Wide-field contact fundus photograph of an infant. Image size 1240x1240. Phoenix ICON, 100° FOV:
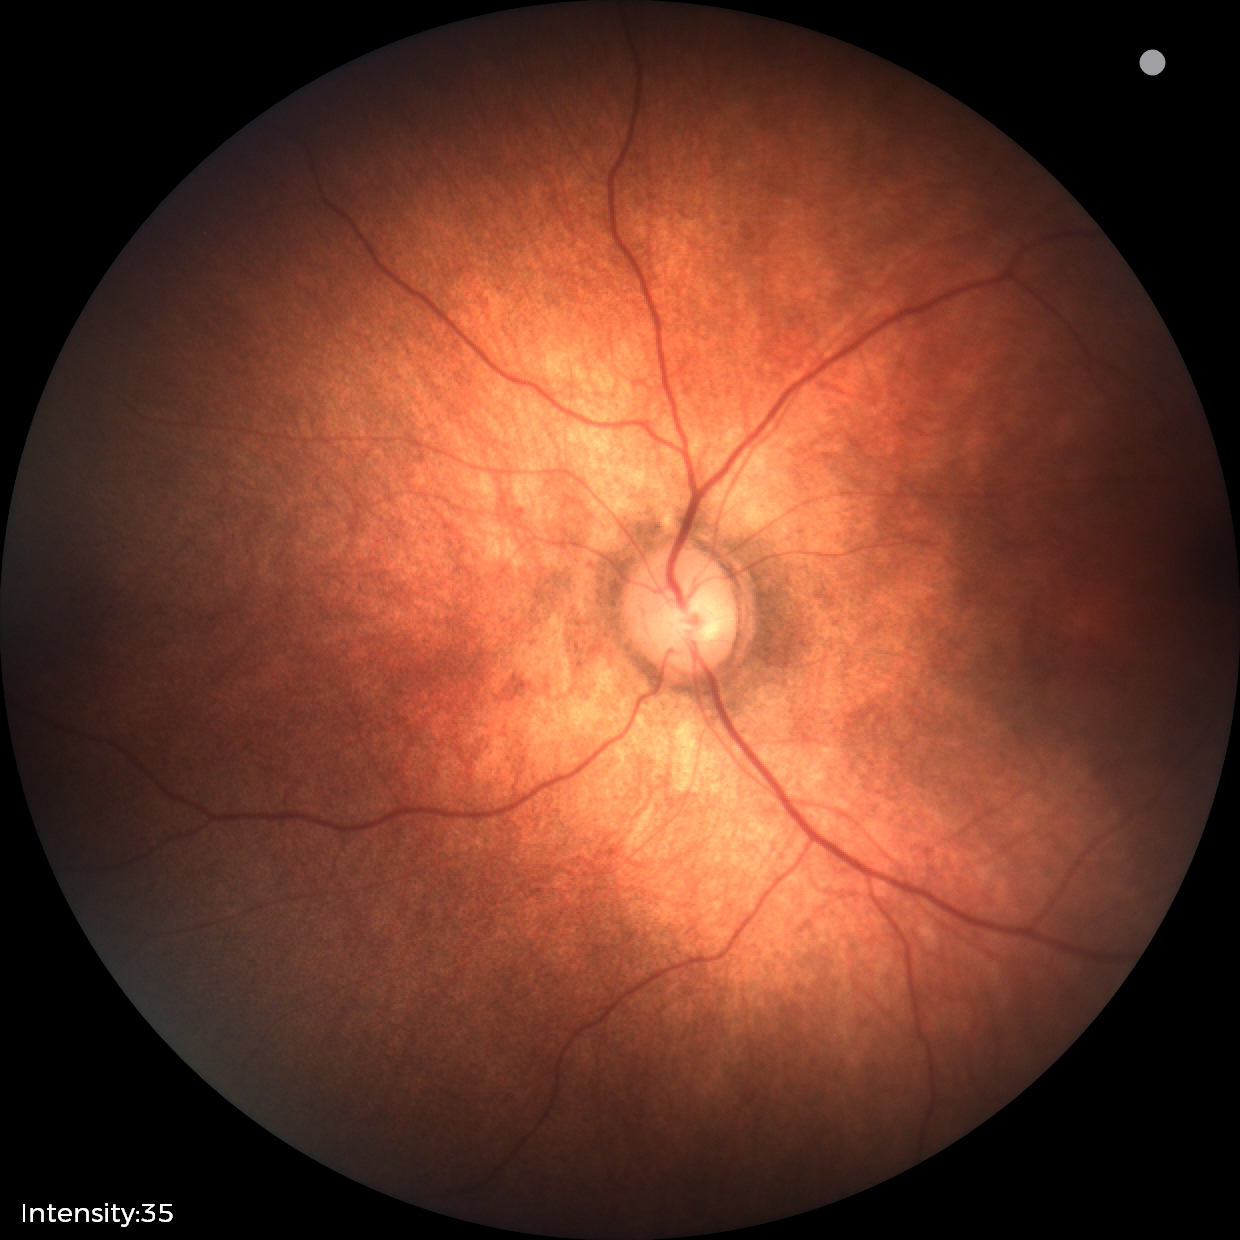

Screening examination diagnosed as physiological.